Color fundus image; image size 848x848.
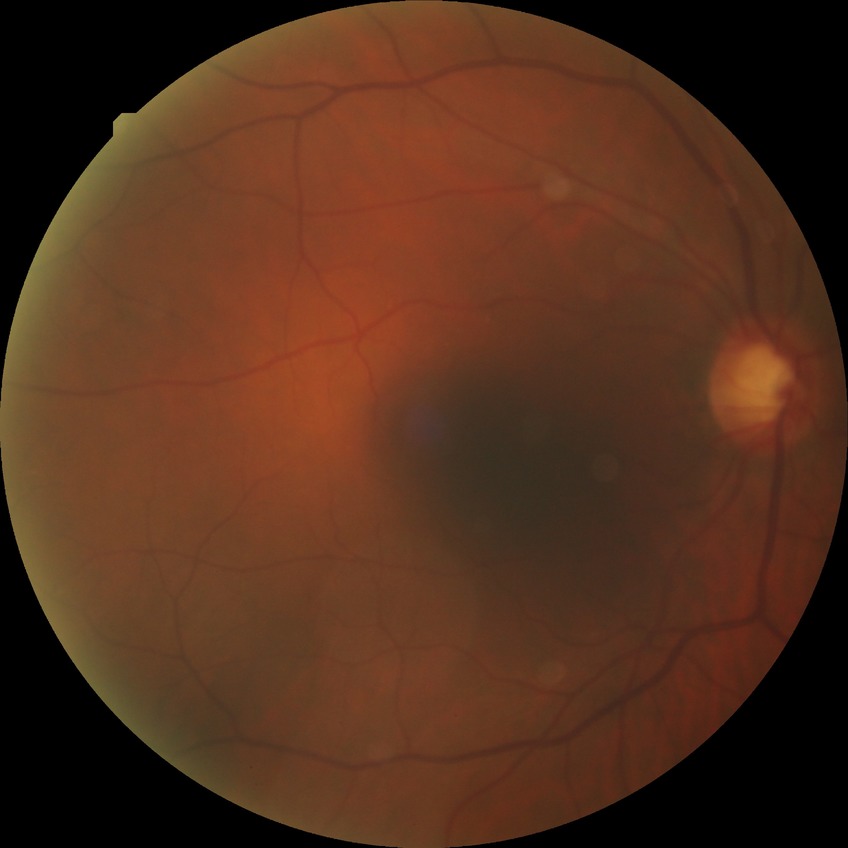
Diabetic retinopathy (DR): no diabetic retinopathy (NDR).